Image size 1240x1240; wide-field fundus photograph from neonatal ROP screening: 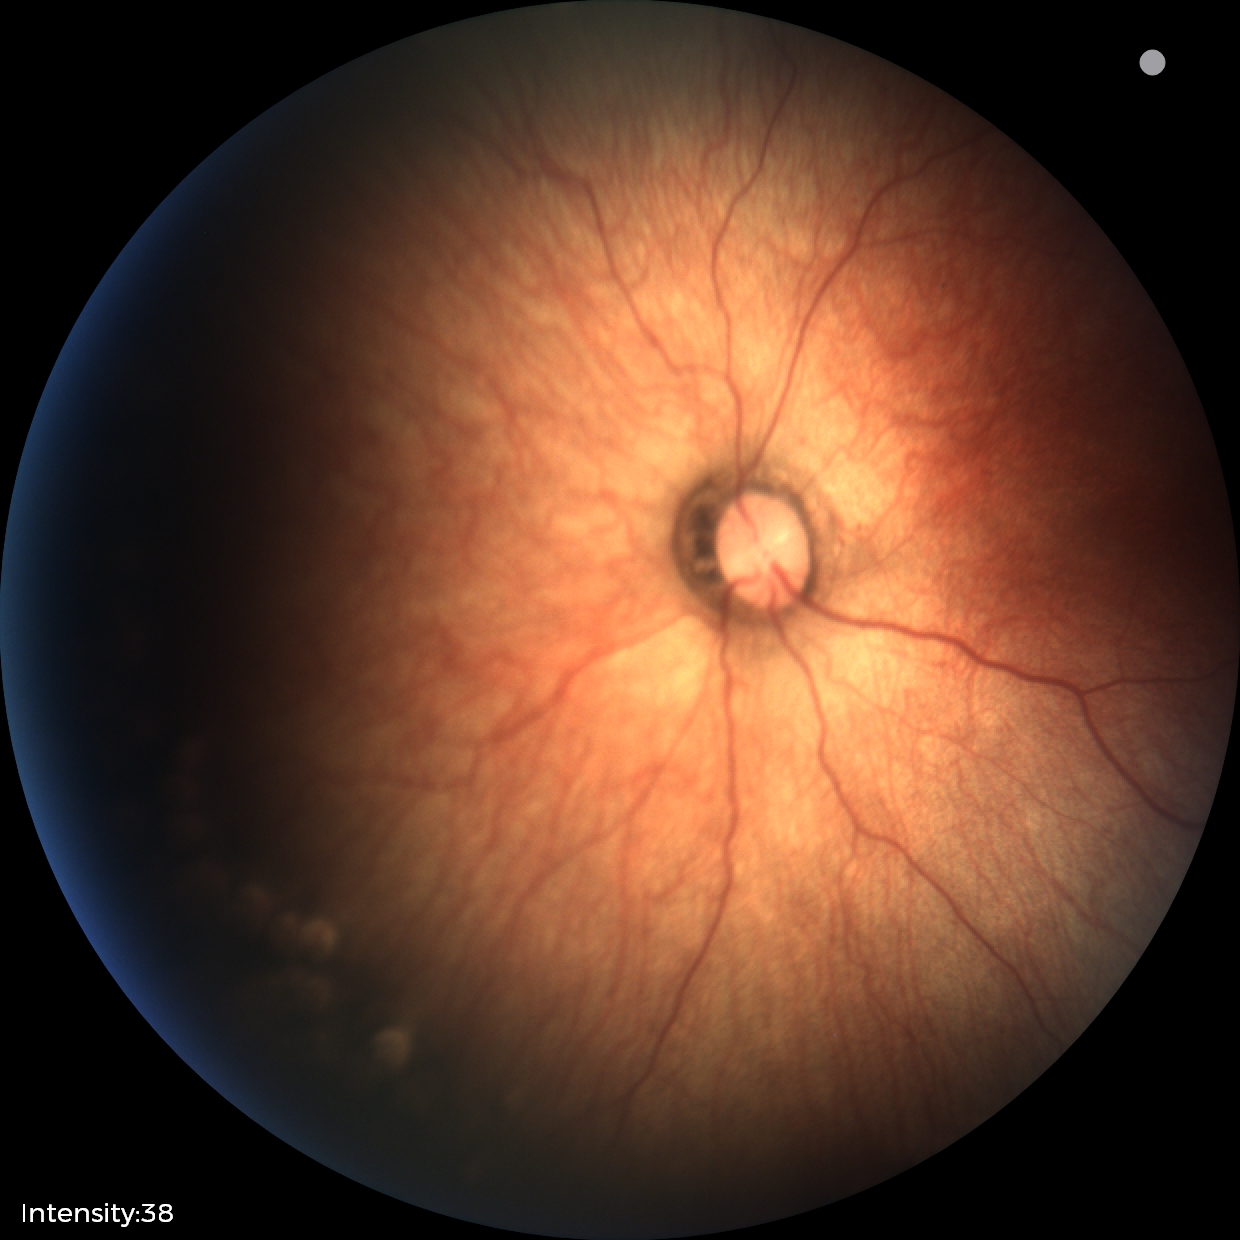

Without plus disease.
Screening examination consistent with status post ROP.